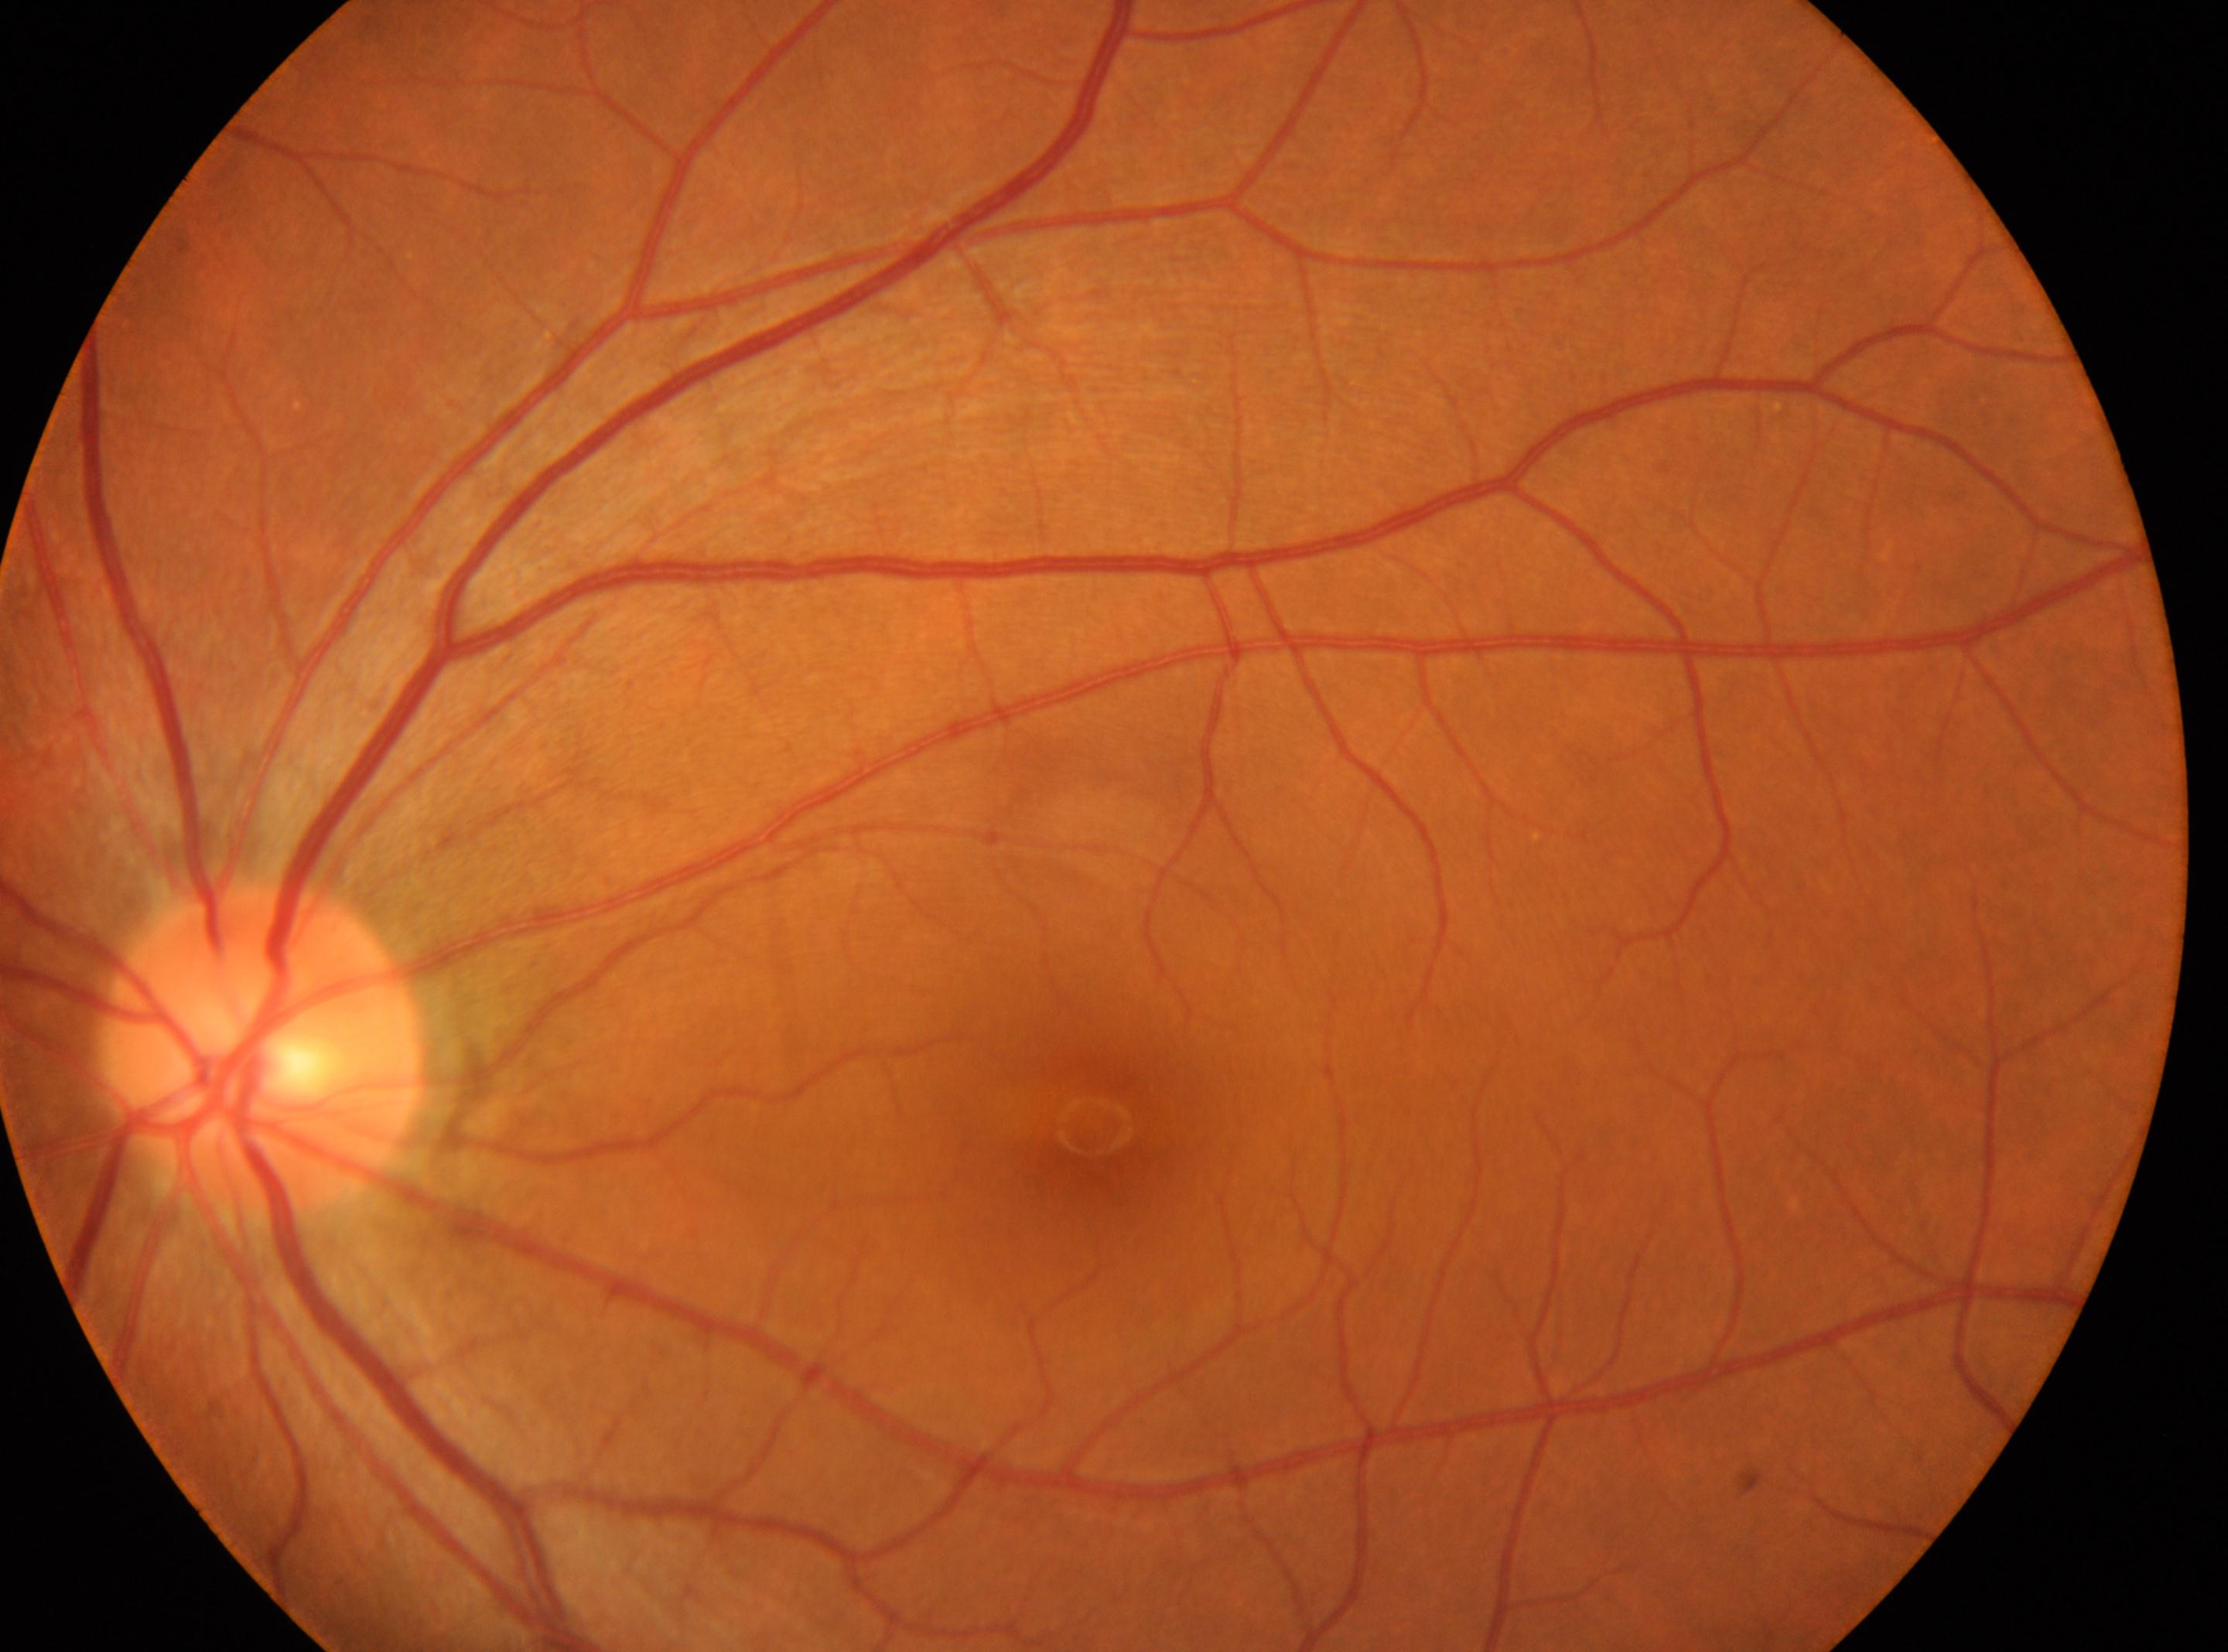   dr_grade: no apparent retinopathy (grade 0)
  fovea: (1092,1125)
  optic_disc: (265,1052)
  eye: left eye